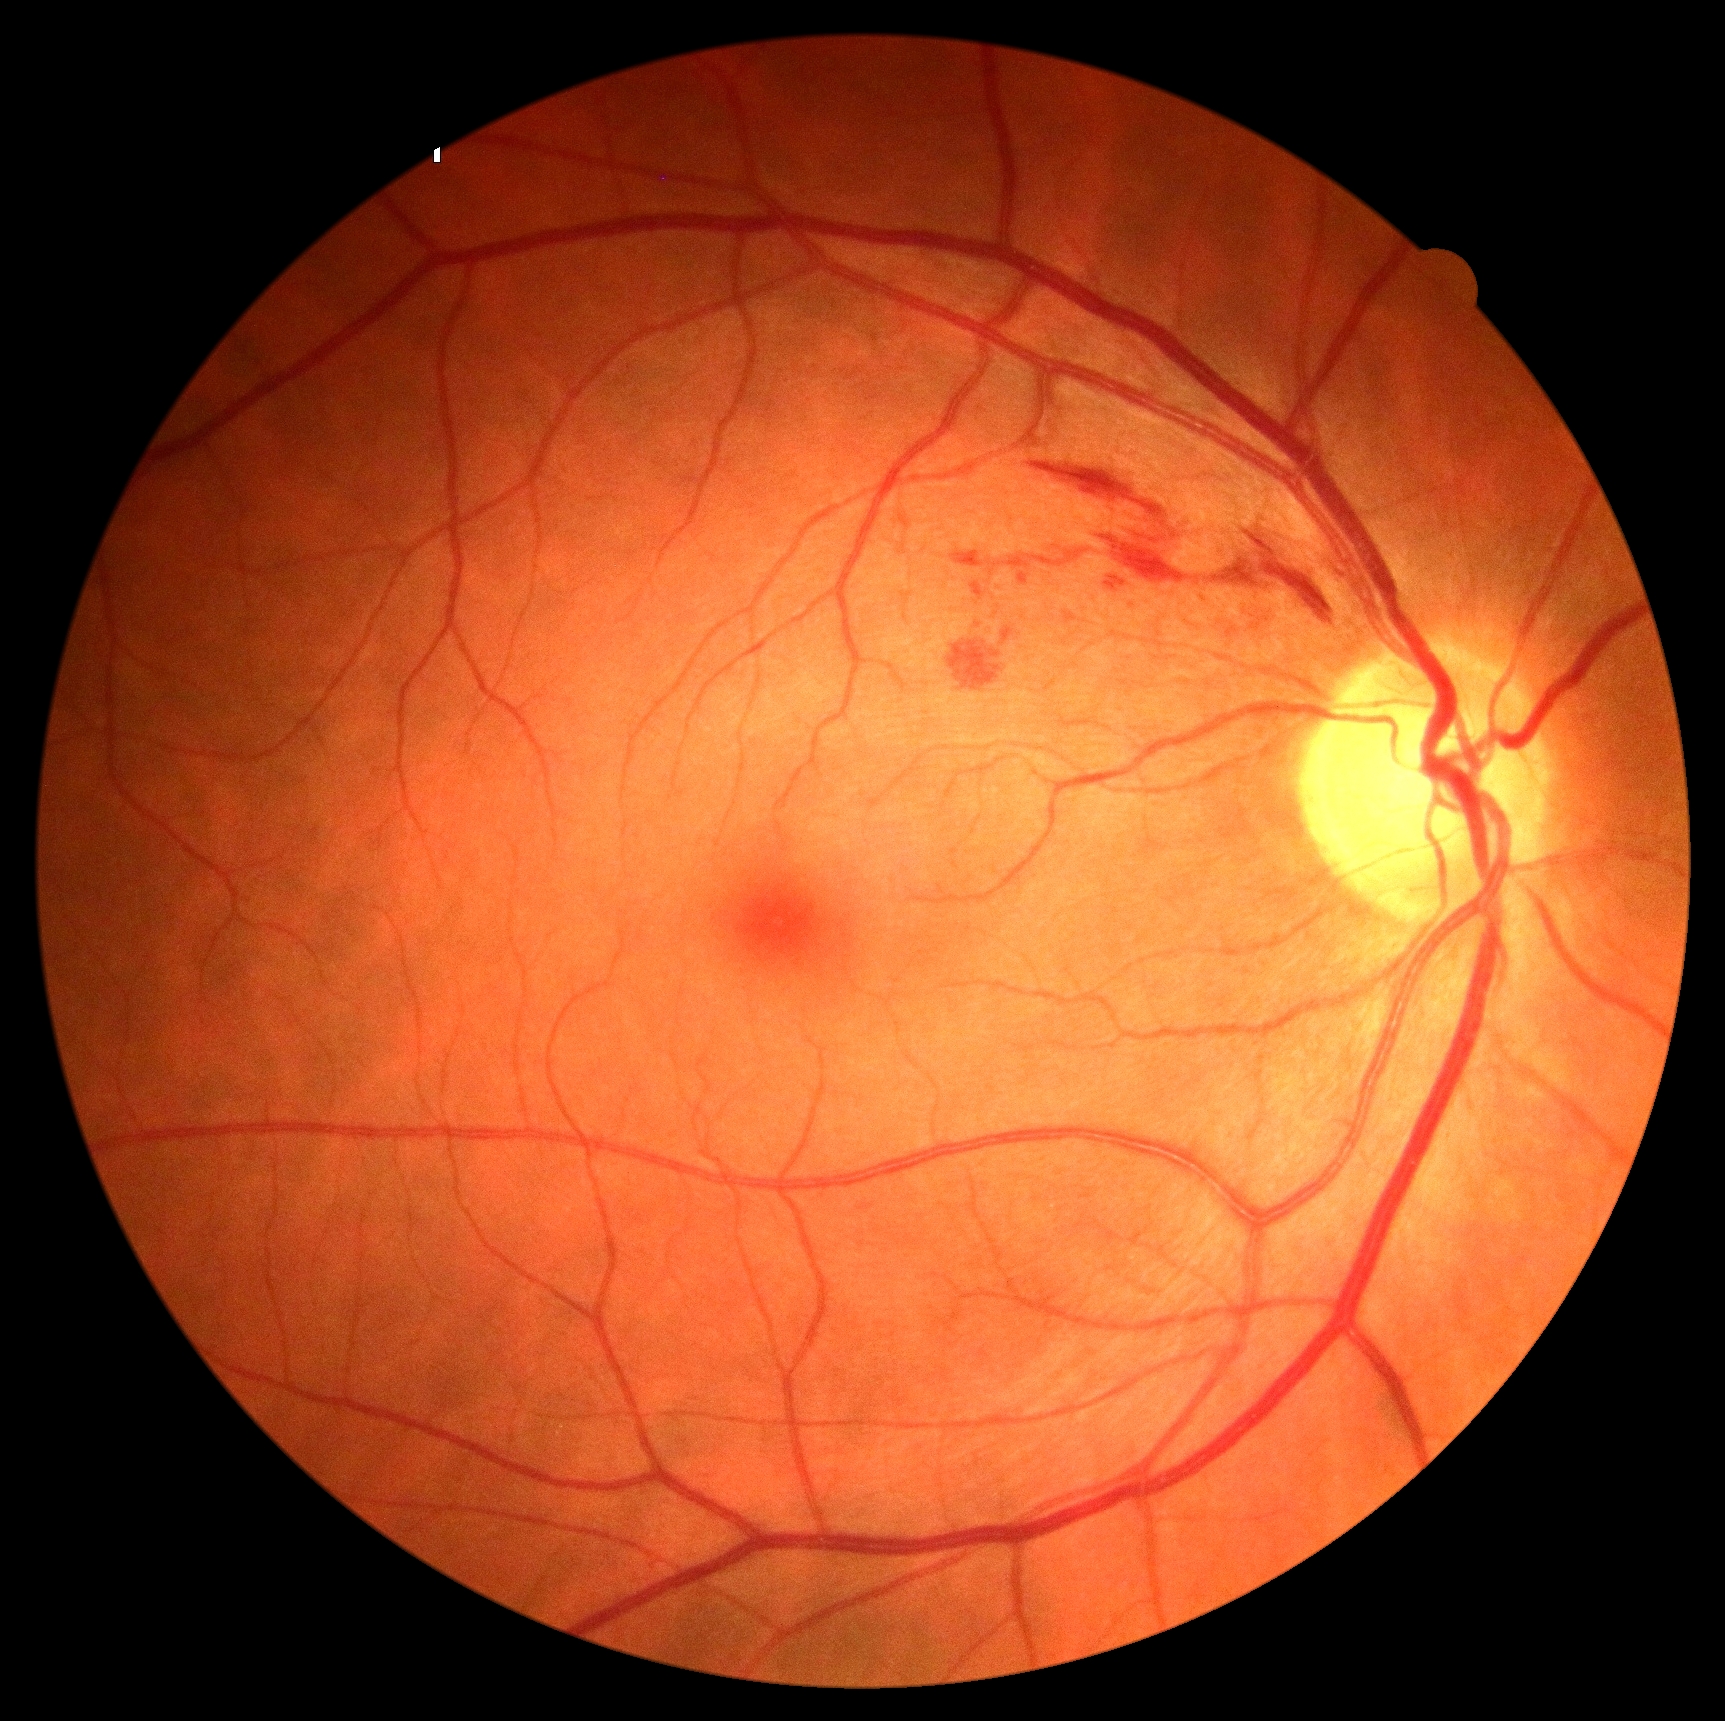

retinopathy=grade 2 (moderate NPDR); DR class=non-proliferative diabetic retinopathy.